848x848px, fundus photo, FOV: 45 degrees, NIDEK AFC-230, nonmydriatic fundus photograph: 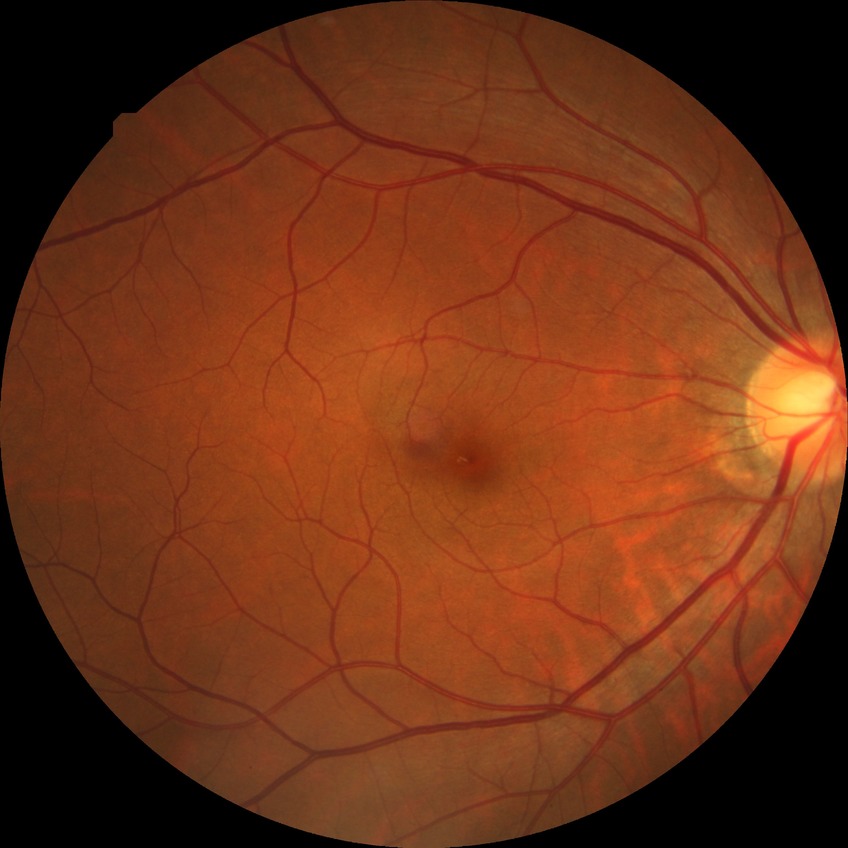 Diabetic retinopathy (DR): no diabetic retinopathy (NDR).